45° field of view — 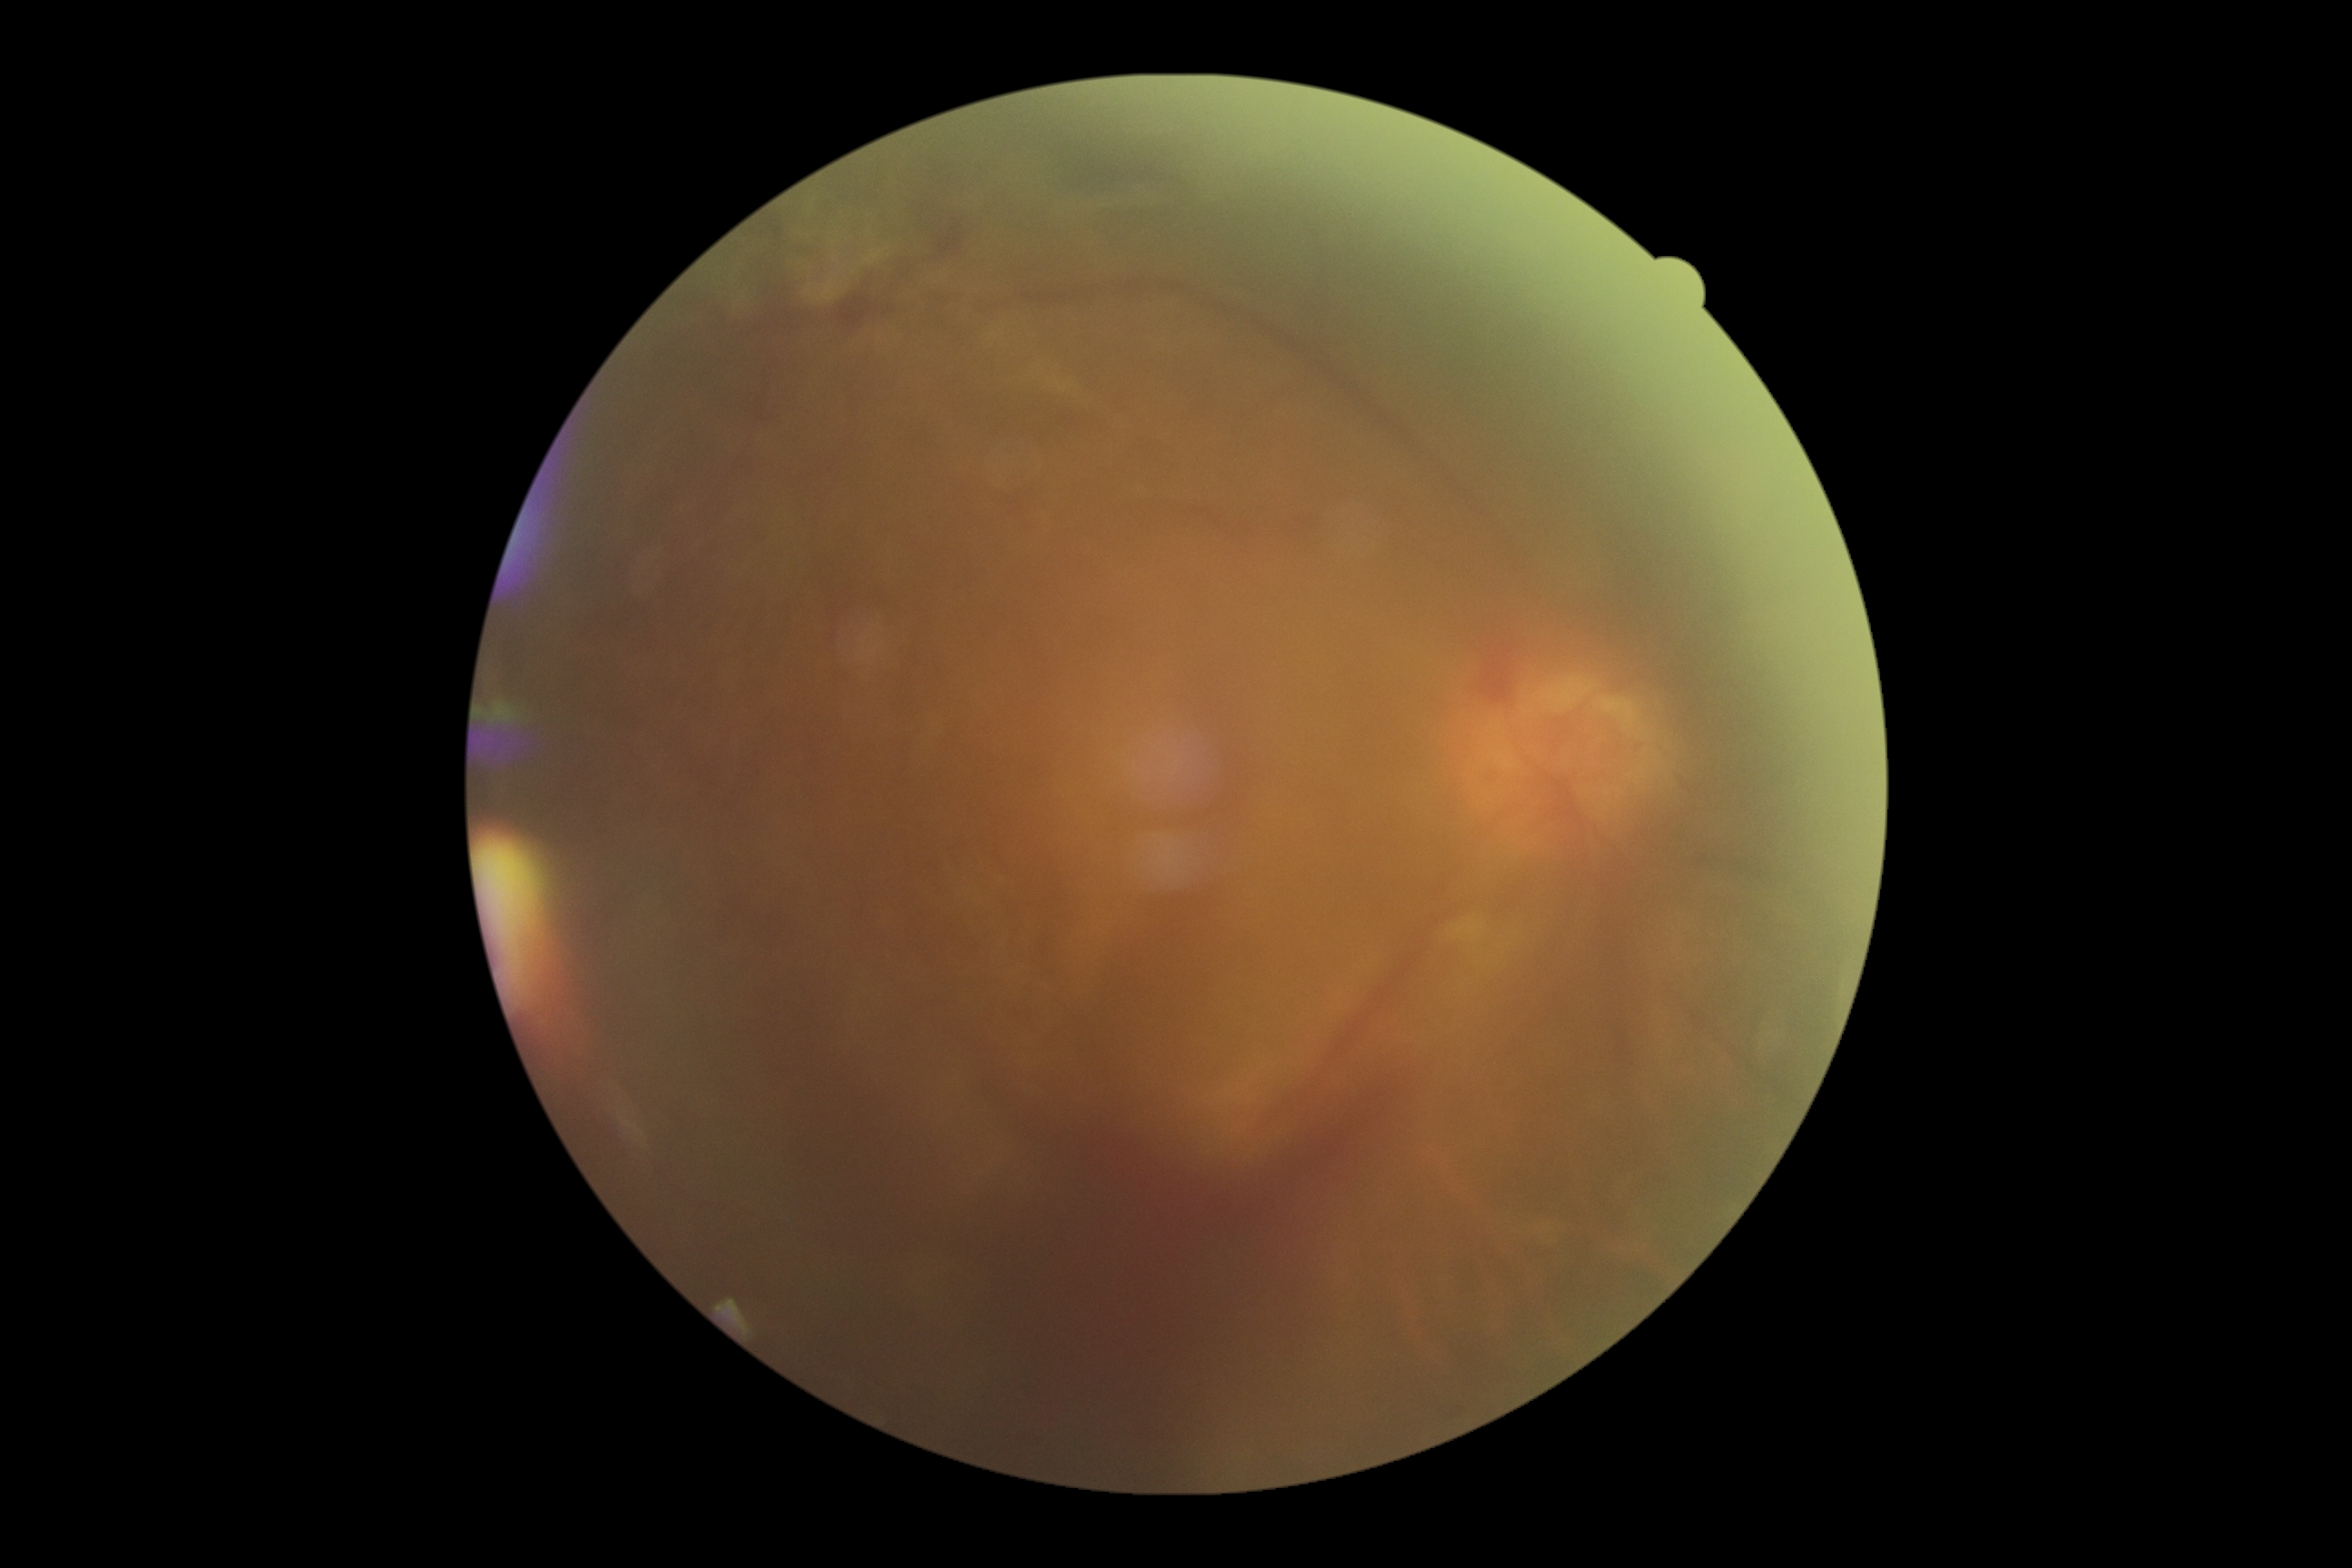 Retinopathy grade: 4 (PDR).